50° field of view: 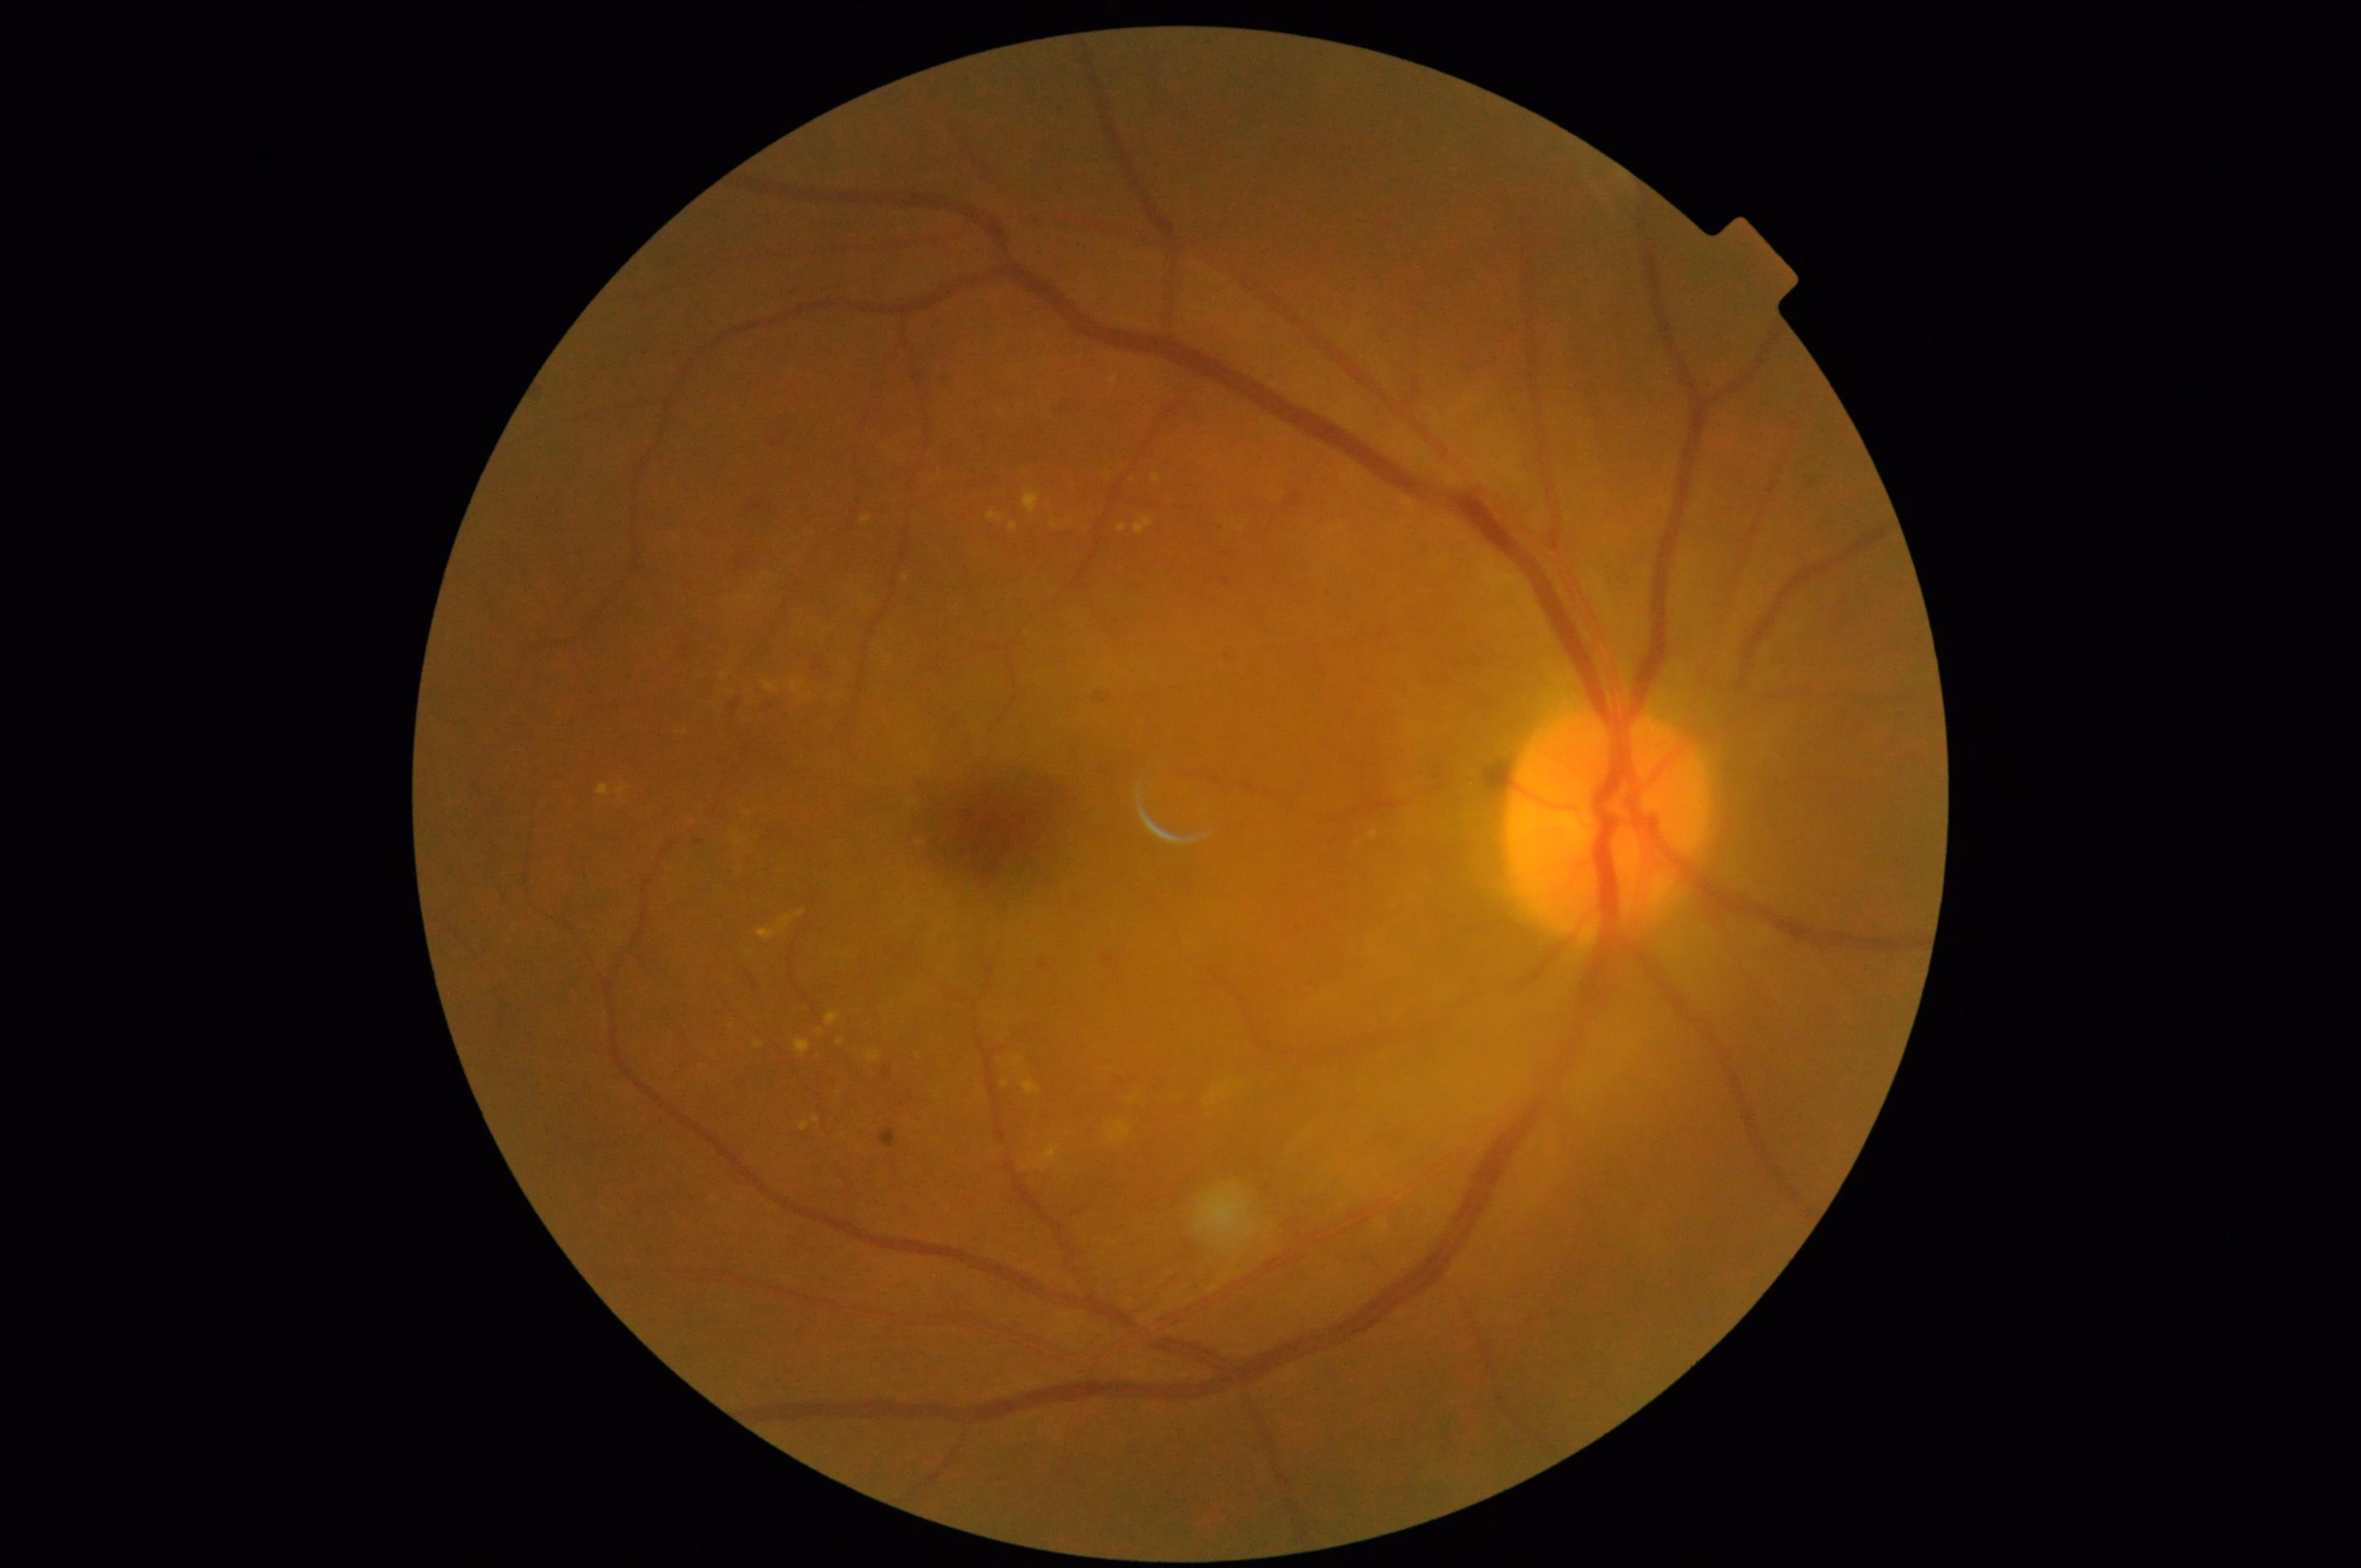 The image is clear. Vessels and details are readily distinguishable. Overall image quality is good. Illumination and color balance are good.